Wide-field fundus photograph from neonatal ROP screening
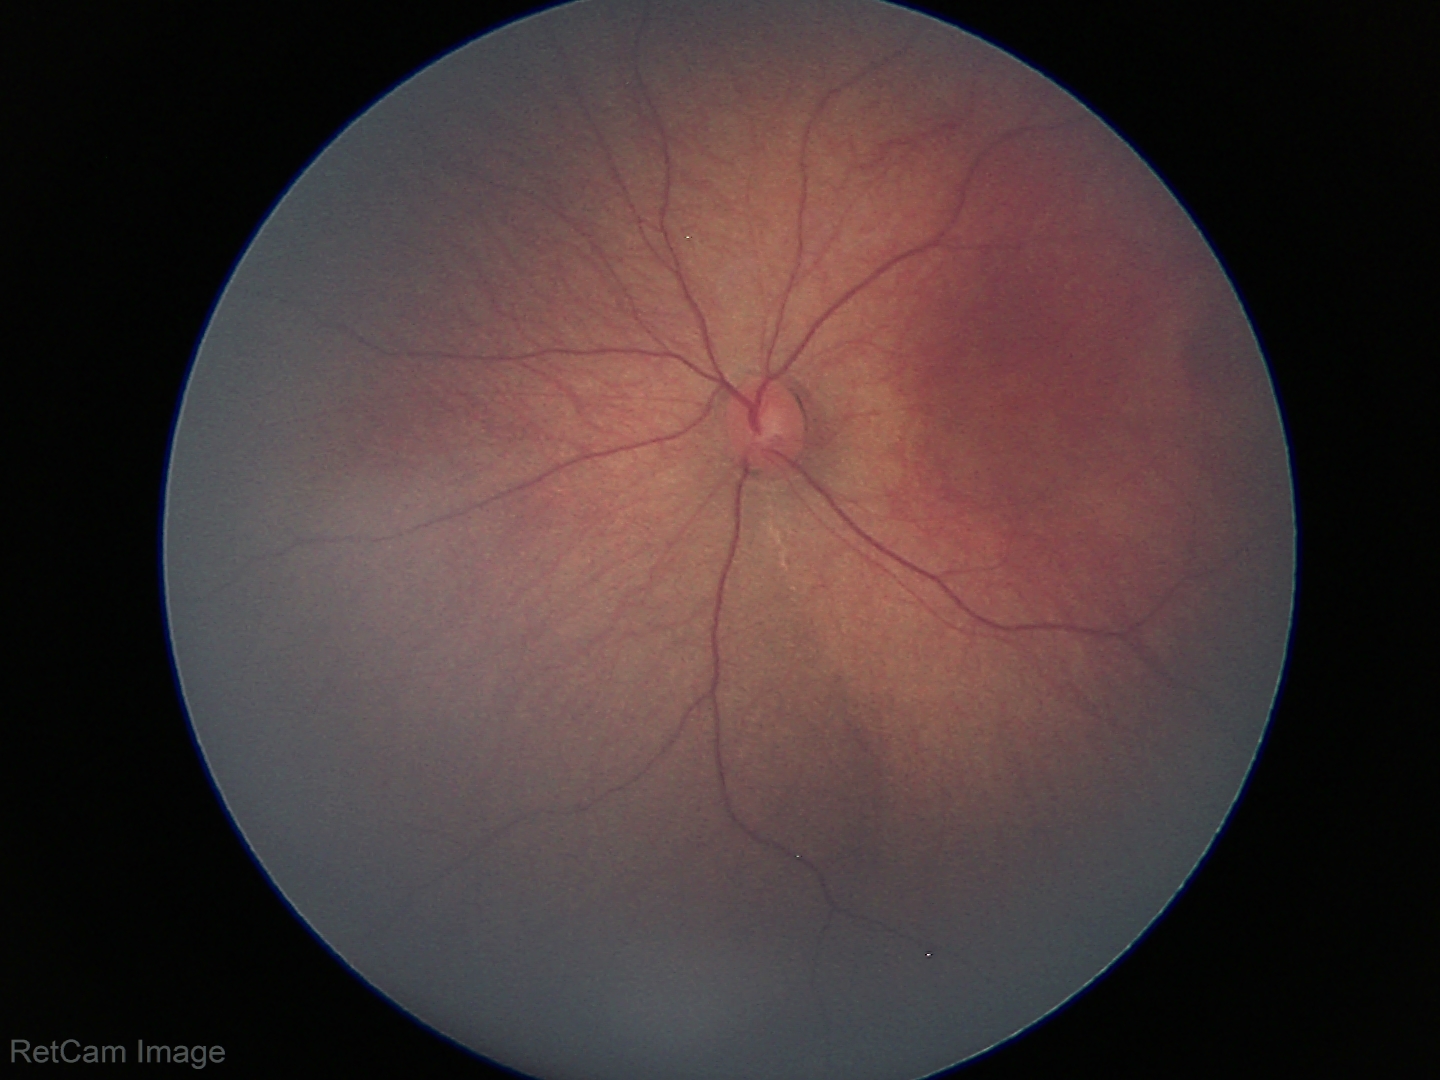 Screening examination with no abnormal retinal findings.